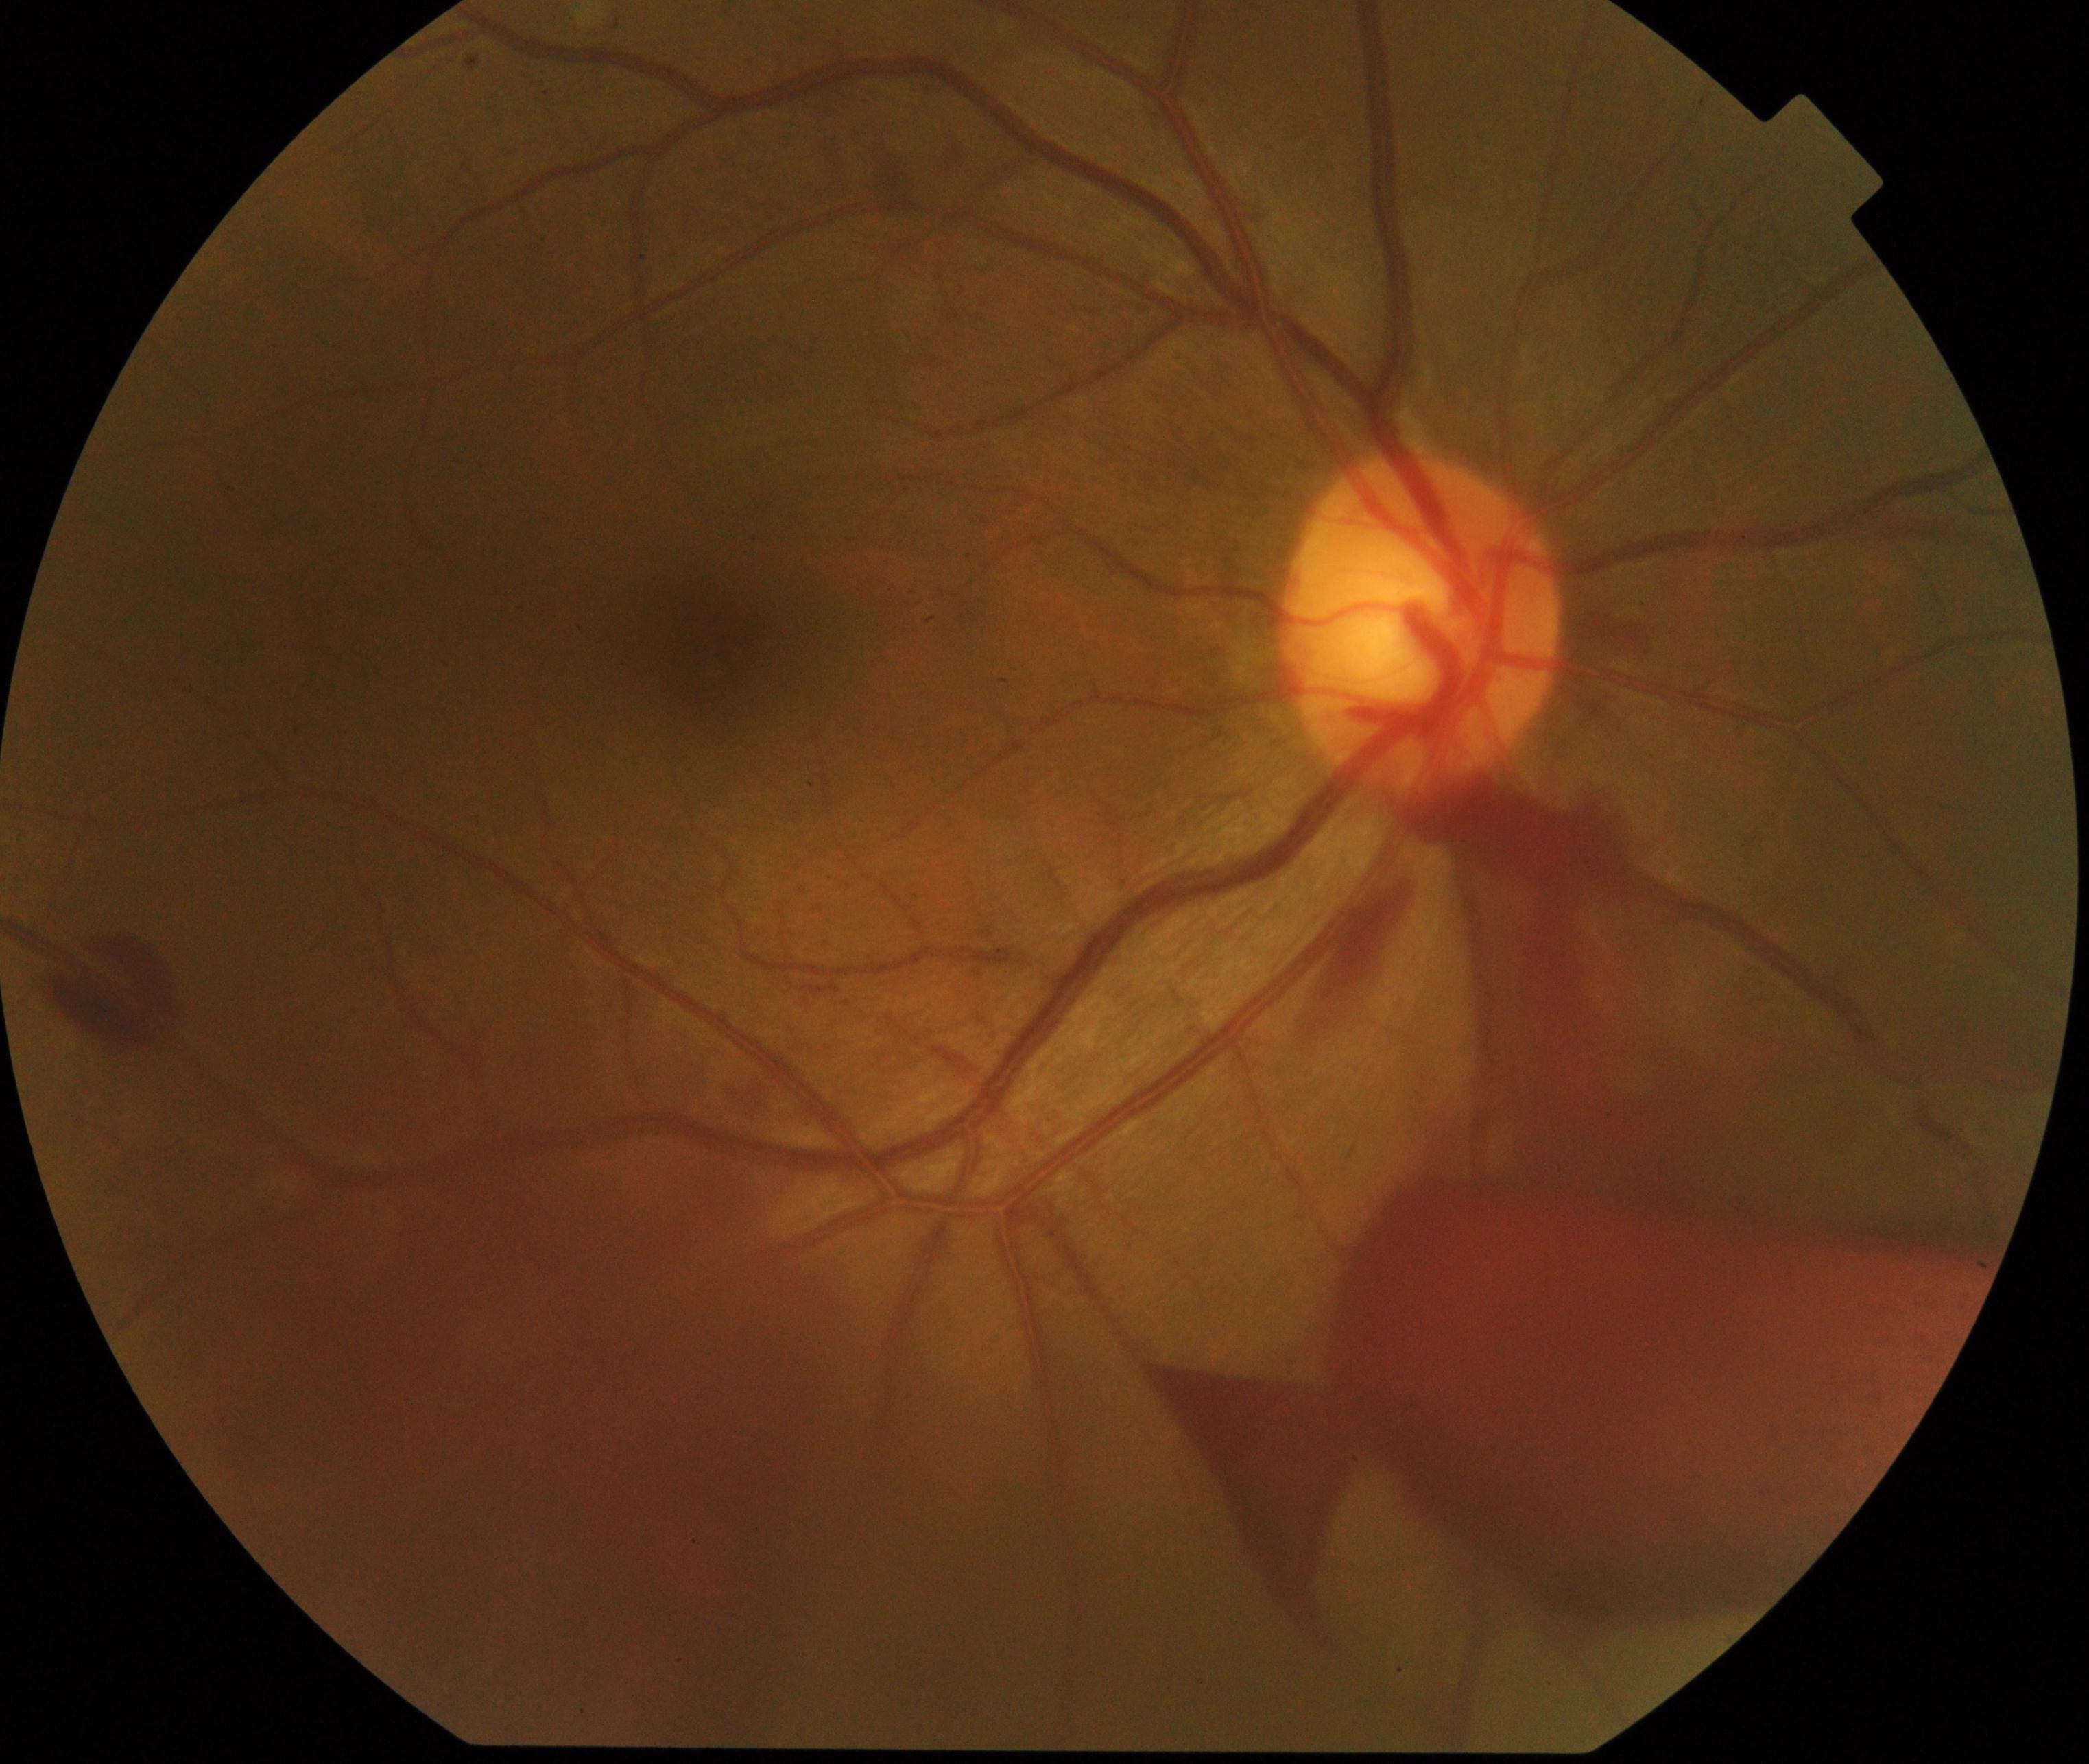

Diagnosis: preretinal hemorrhage.